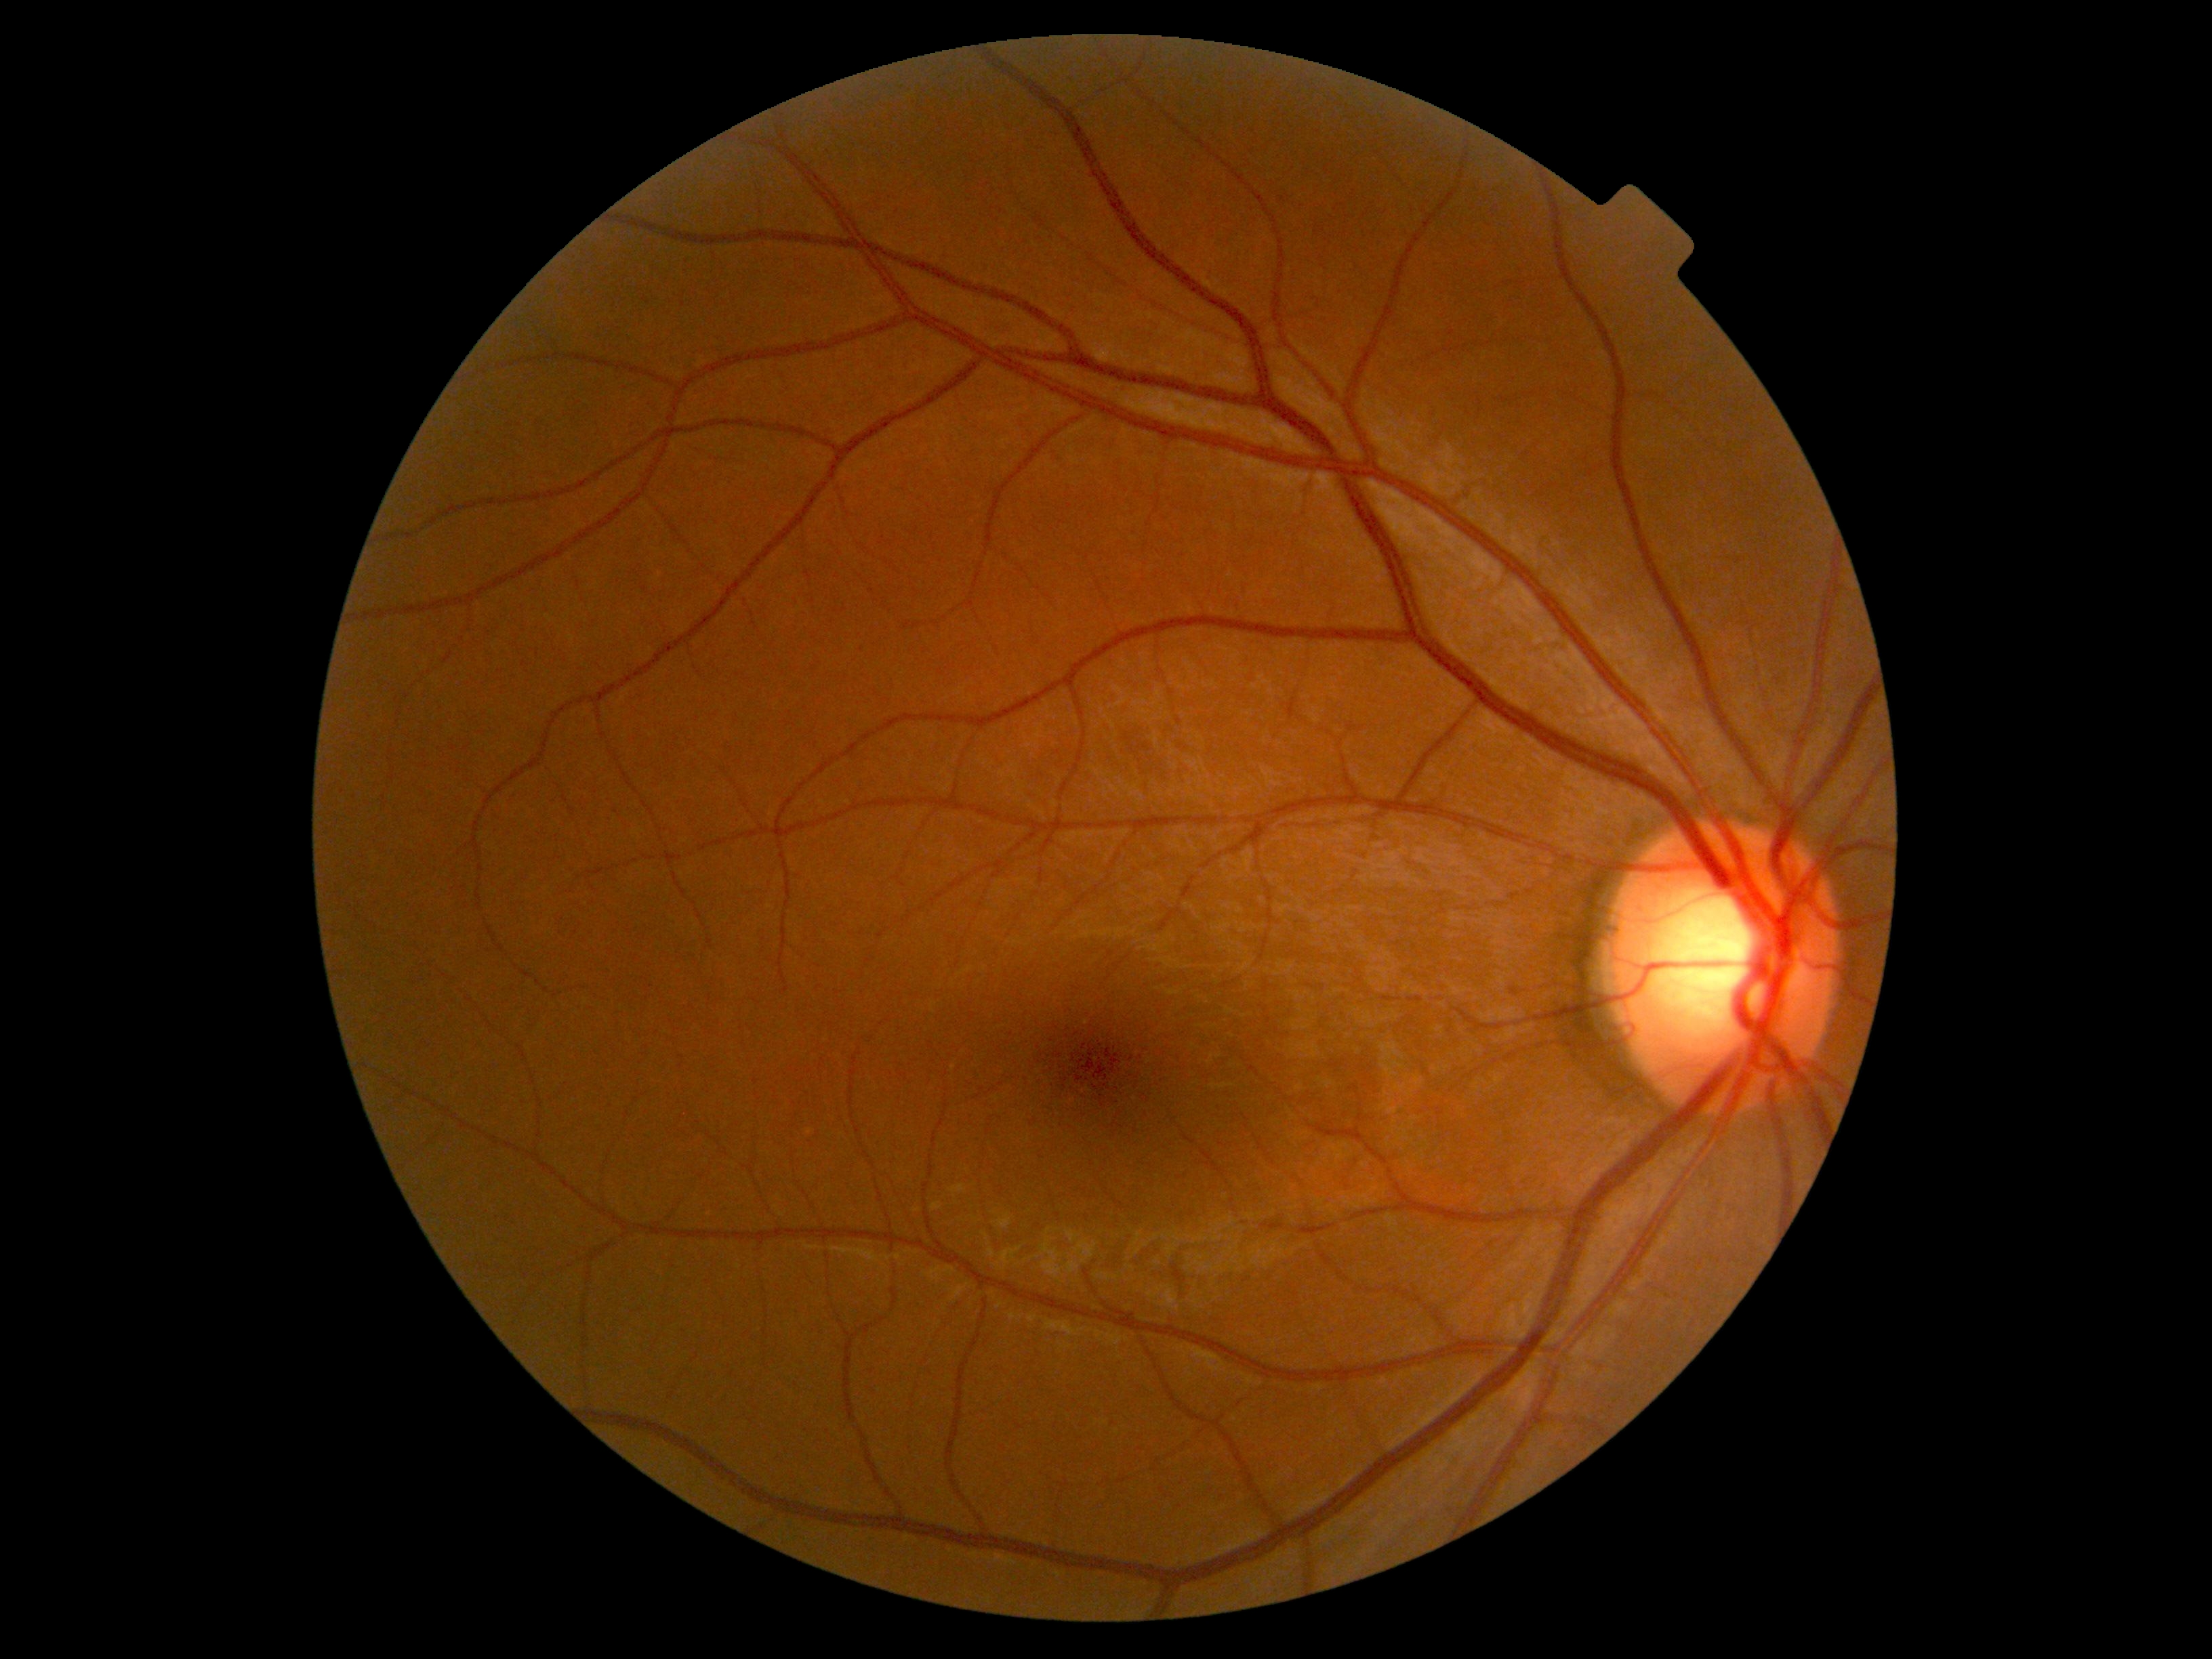 diabetic retinopathy = no apparent retinopathy (grade 0) — no visible signs of diabetic retinopathy.